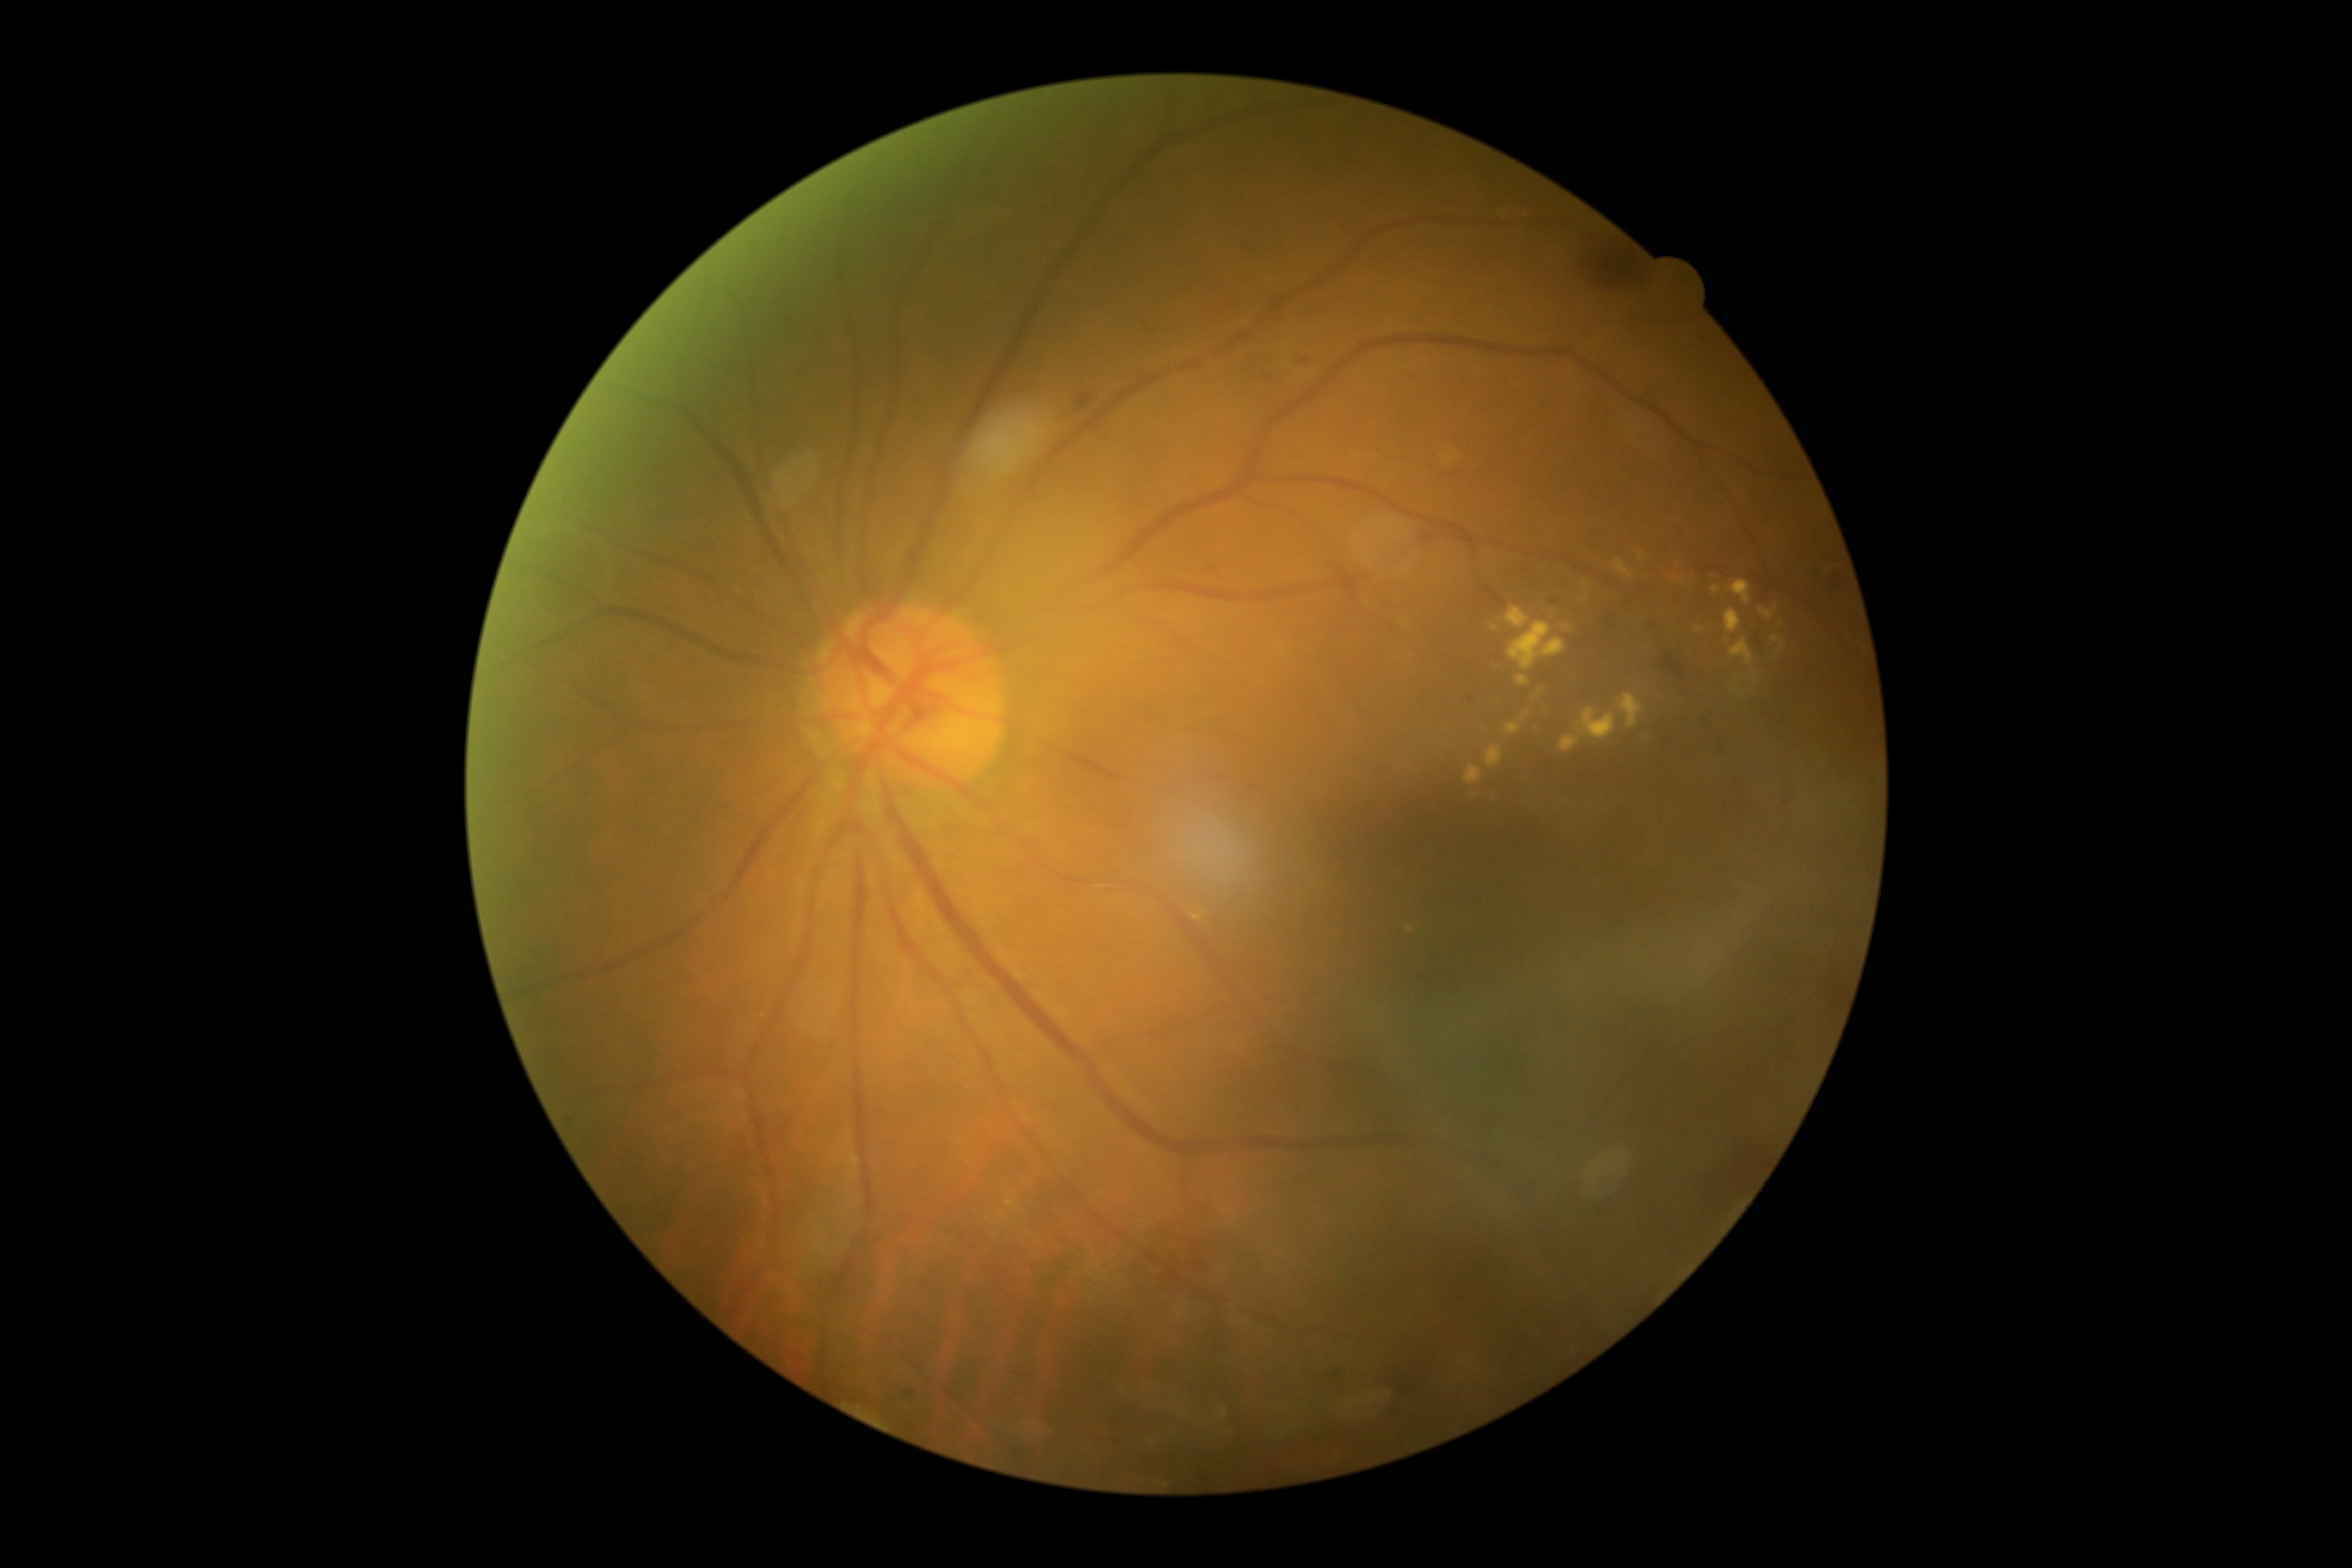

Diabetic retinopathy is moderate NPDR (grade 2)
A subset of detected lesions:
soft exudates: none detected
hemorrhages: 1540:663:1562:694 | 1079:395:1093:410 | 1822:575:1846:592 | 1139:1222:1196:1292 | 1552:599:1560:606 | 1593:248:1641:288 | 1388:1359:1426:1400 | 1662:654:1684:678 | 1332:1373:1342:1378
hard exudates (subset): 1464:766:1483:787 | 1674:580:1682:584 | 1619:694:1645:728 | 1507:622:1565:670 | 1519:711:1529:723 | 1505:723:1521:735 | 1639:553:1646:561 | 1725:609:1741:634 | 1614:560:1636:580 | 1727:580:1751:606 | 1751:670:1760:680
Small hard exudates approximately at <pt>1584,600</pt> | <pt>1494,628</pt>
microaneurysms: 907:1390:914:1399 | 787:314:797:322
Small microaneurysms approximately at <pt>1305,362</pt> | <pt>1471,699</pt> | <pt>1212,570</pt>